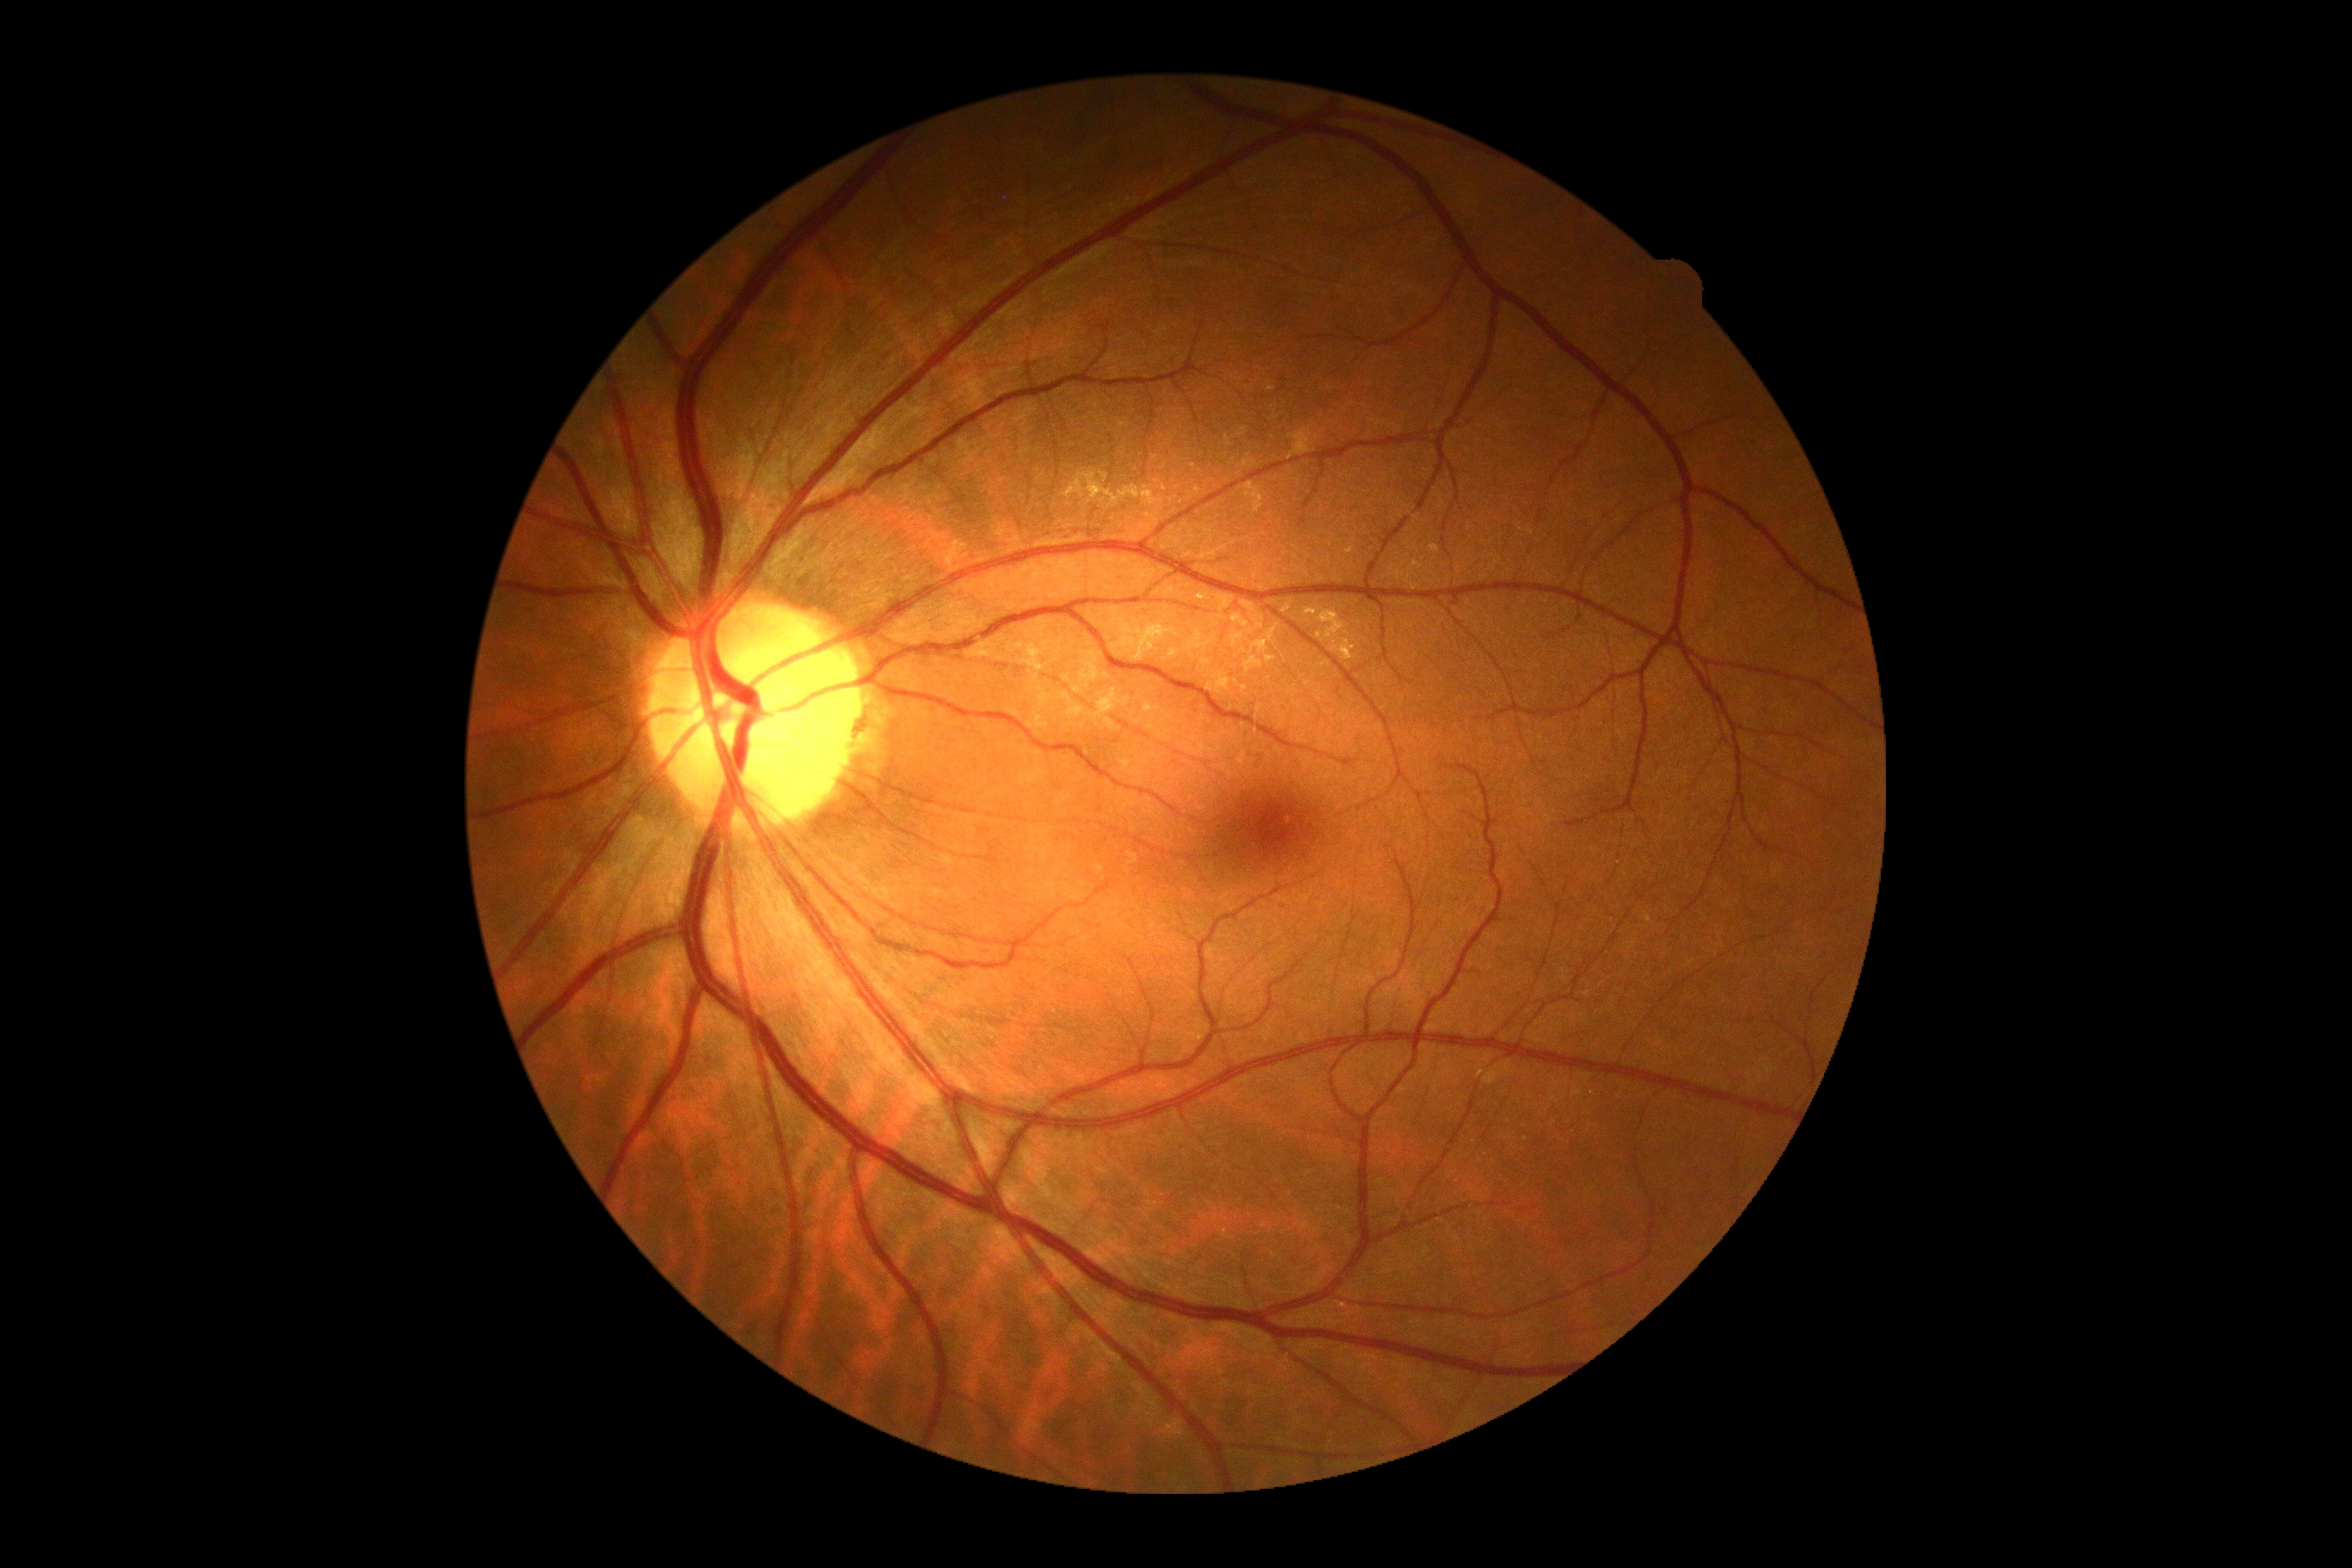

DR grade is 0 (no apparent retinopathy).